Image size 240x240:
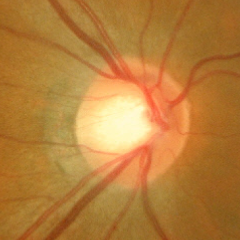

Optic disc photograph demonstrating no glaucomatous optic neuropathy.